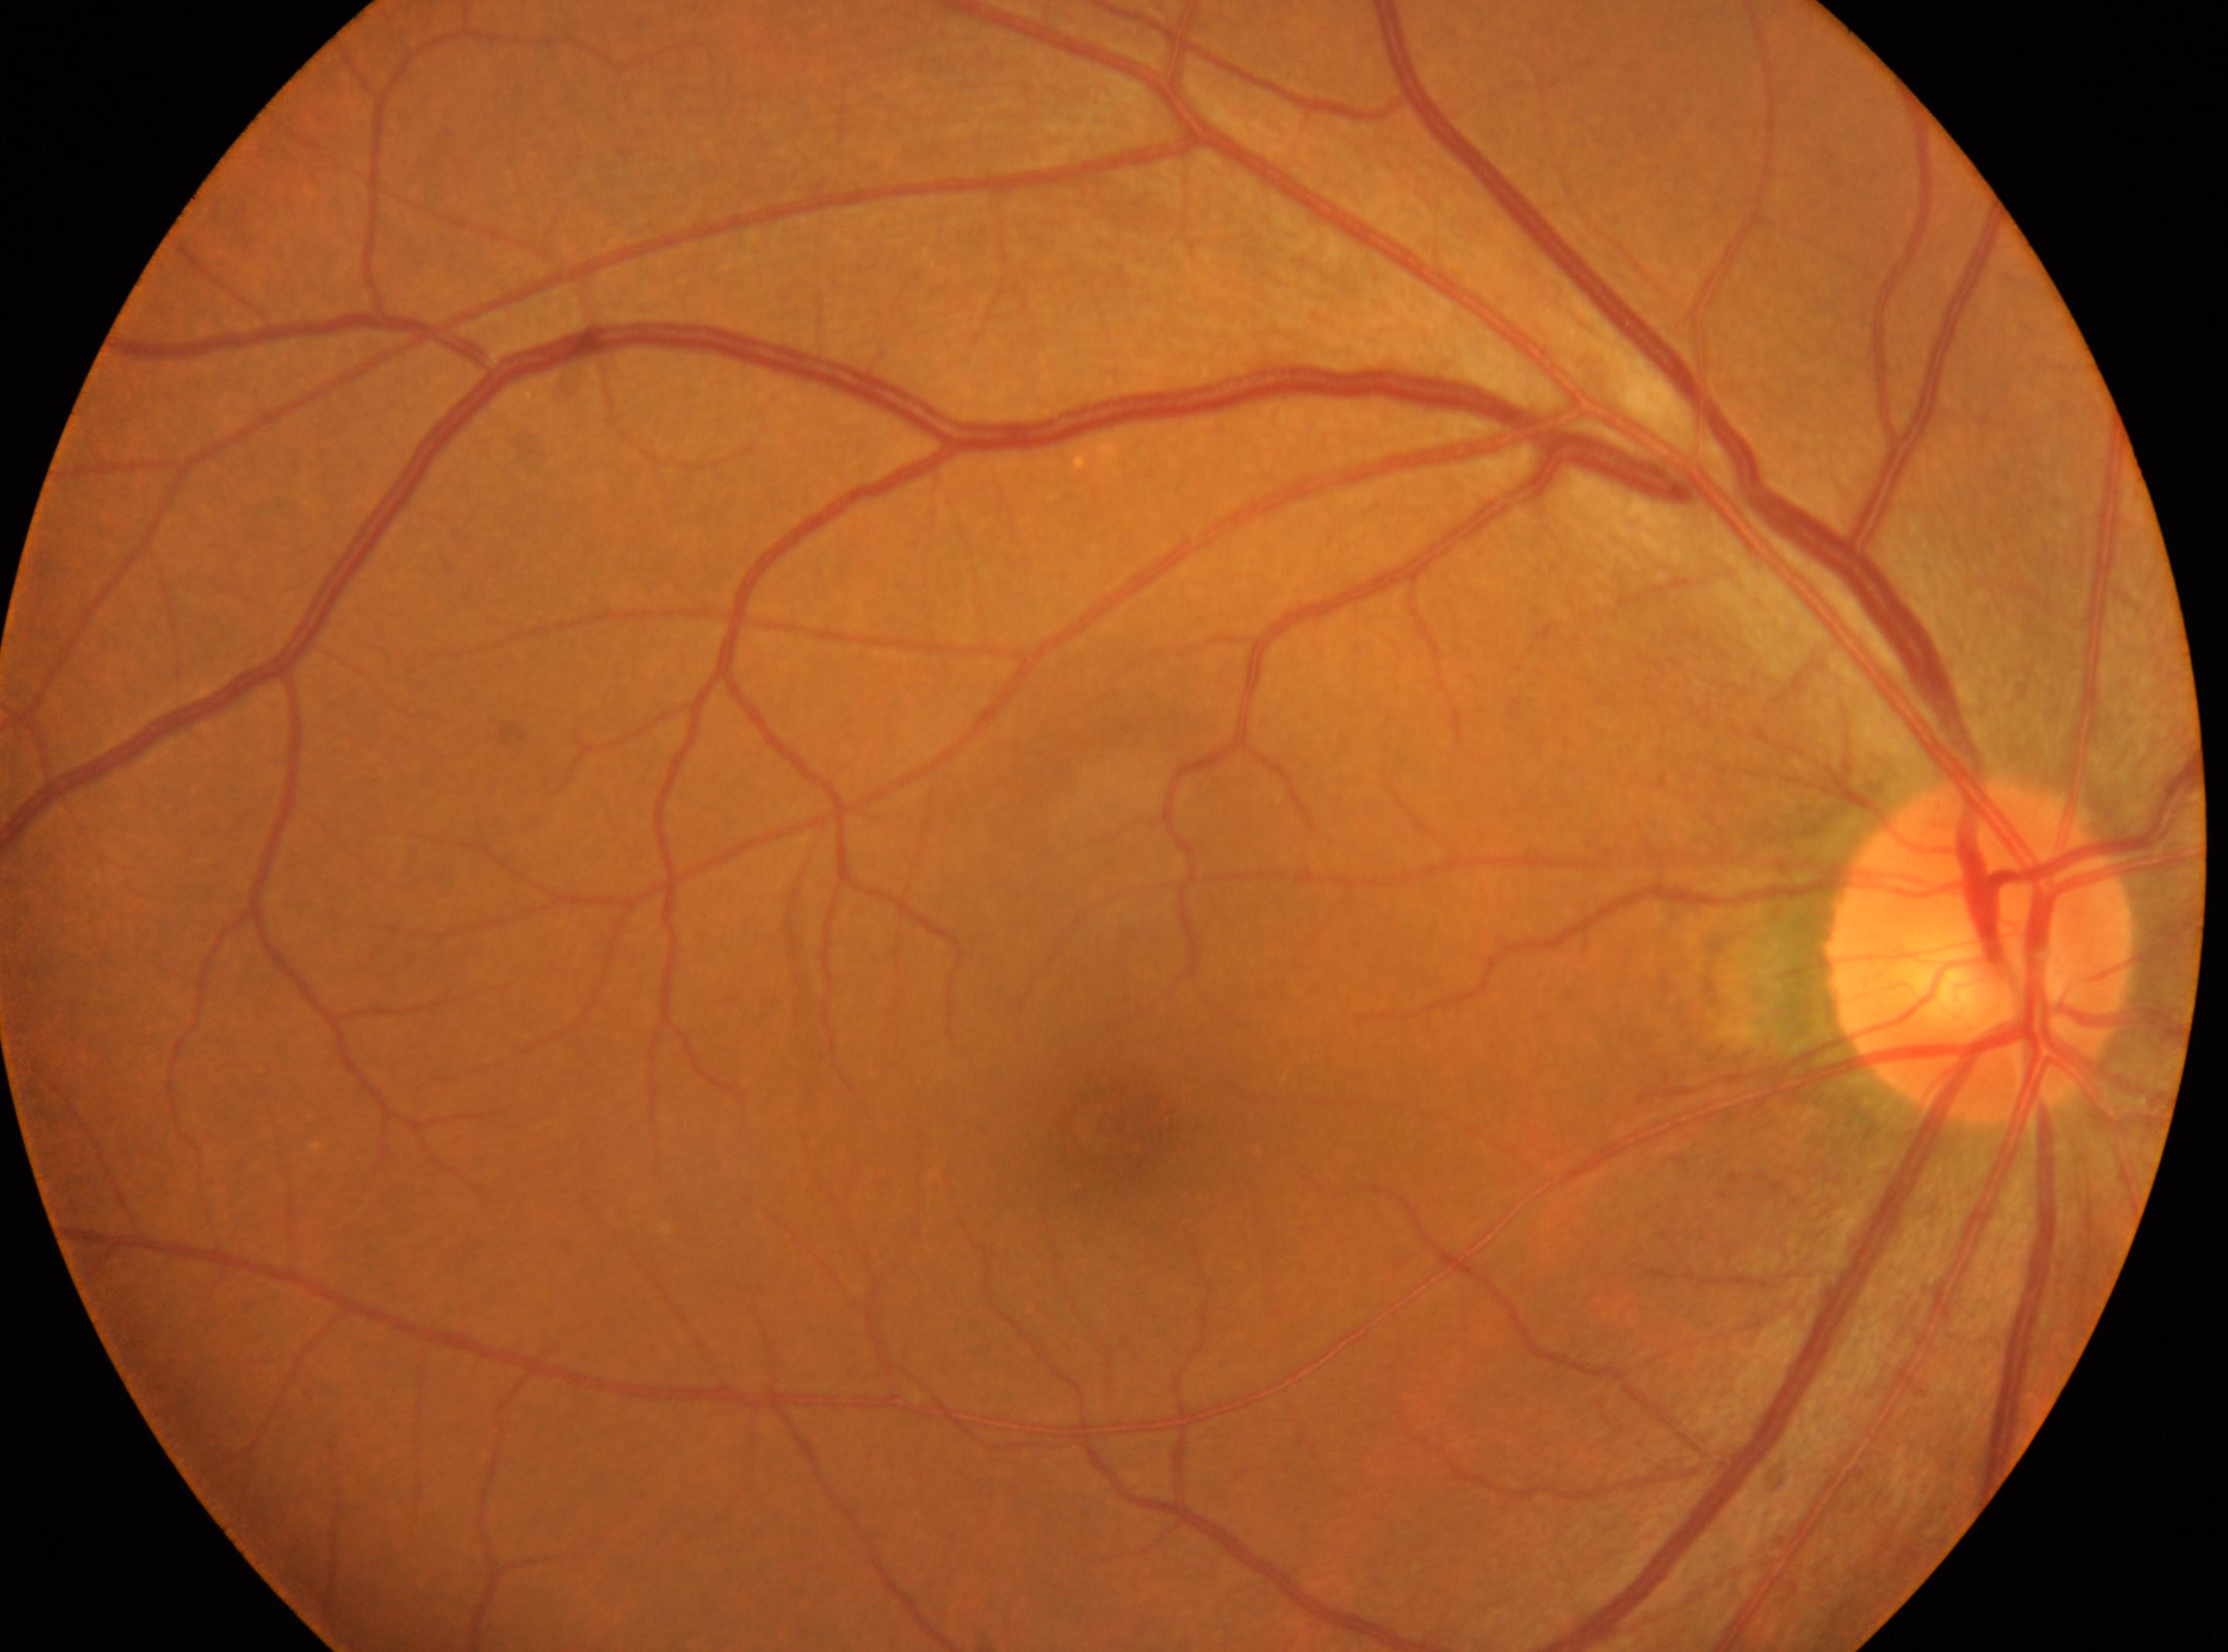

The fovea center is at (x=1114, y=1121). No diabetic retinopathy identified. Optic nerve head: (x=1982, y=951). This is the OD. DR severity is grade 0 (no apparent retinopathy).